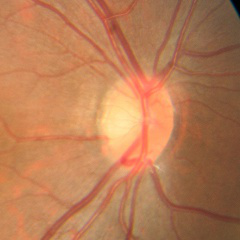 Impression = no evidence of glaucoma.